2352 x 1568 pixels.
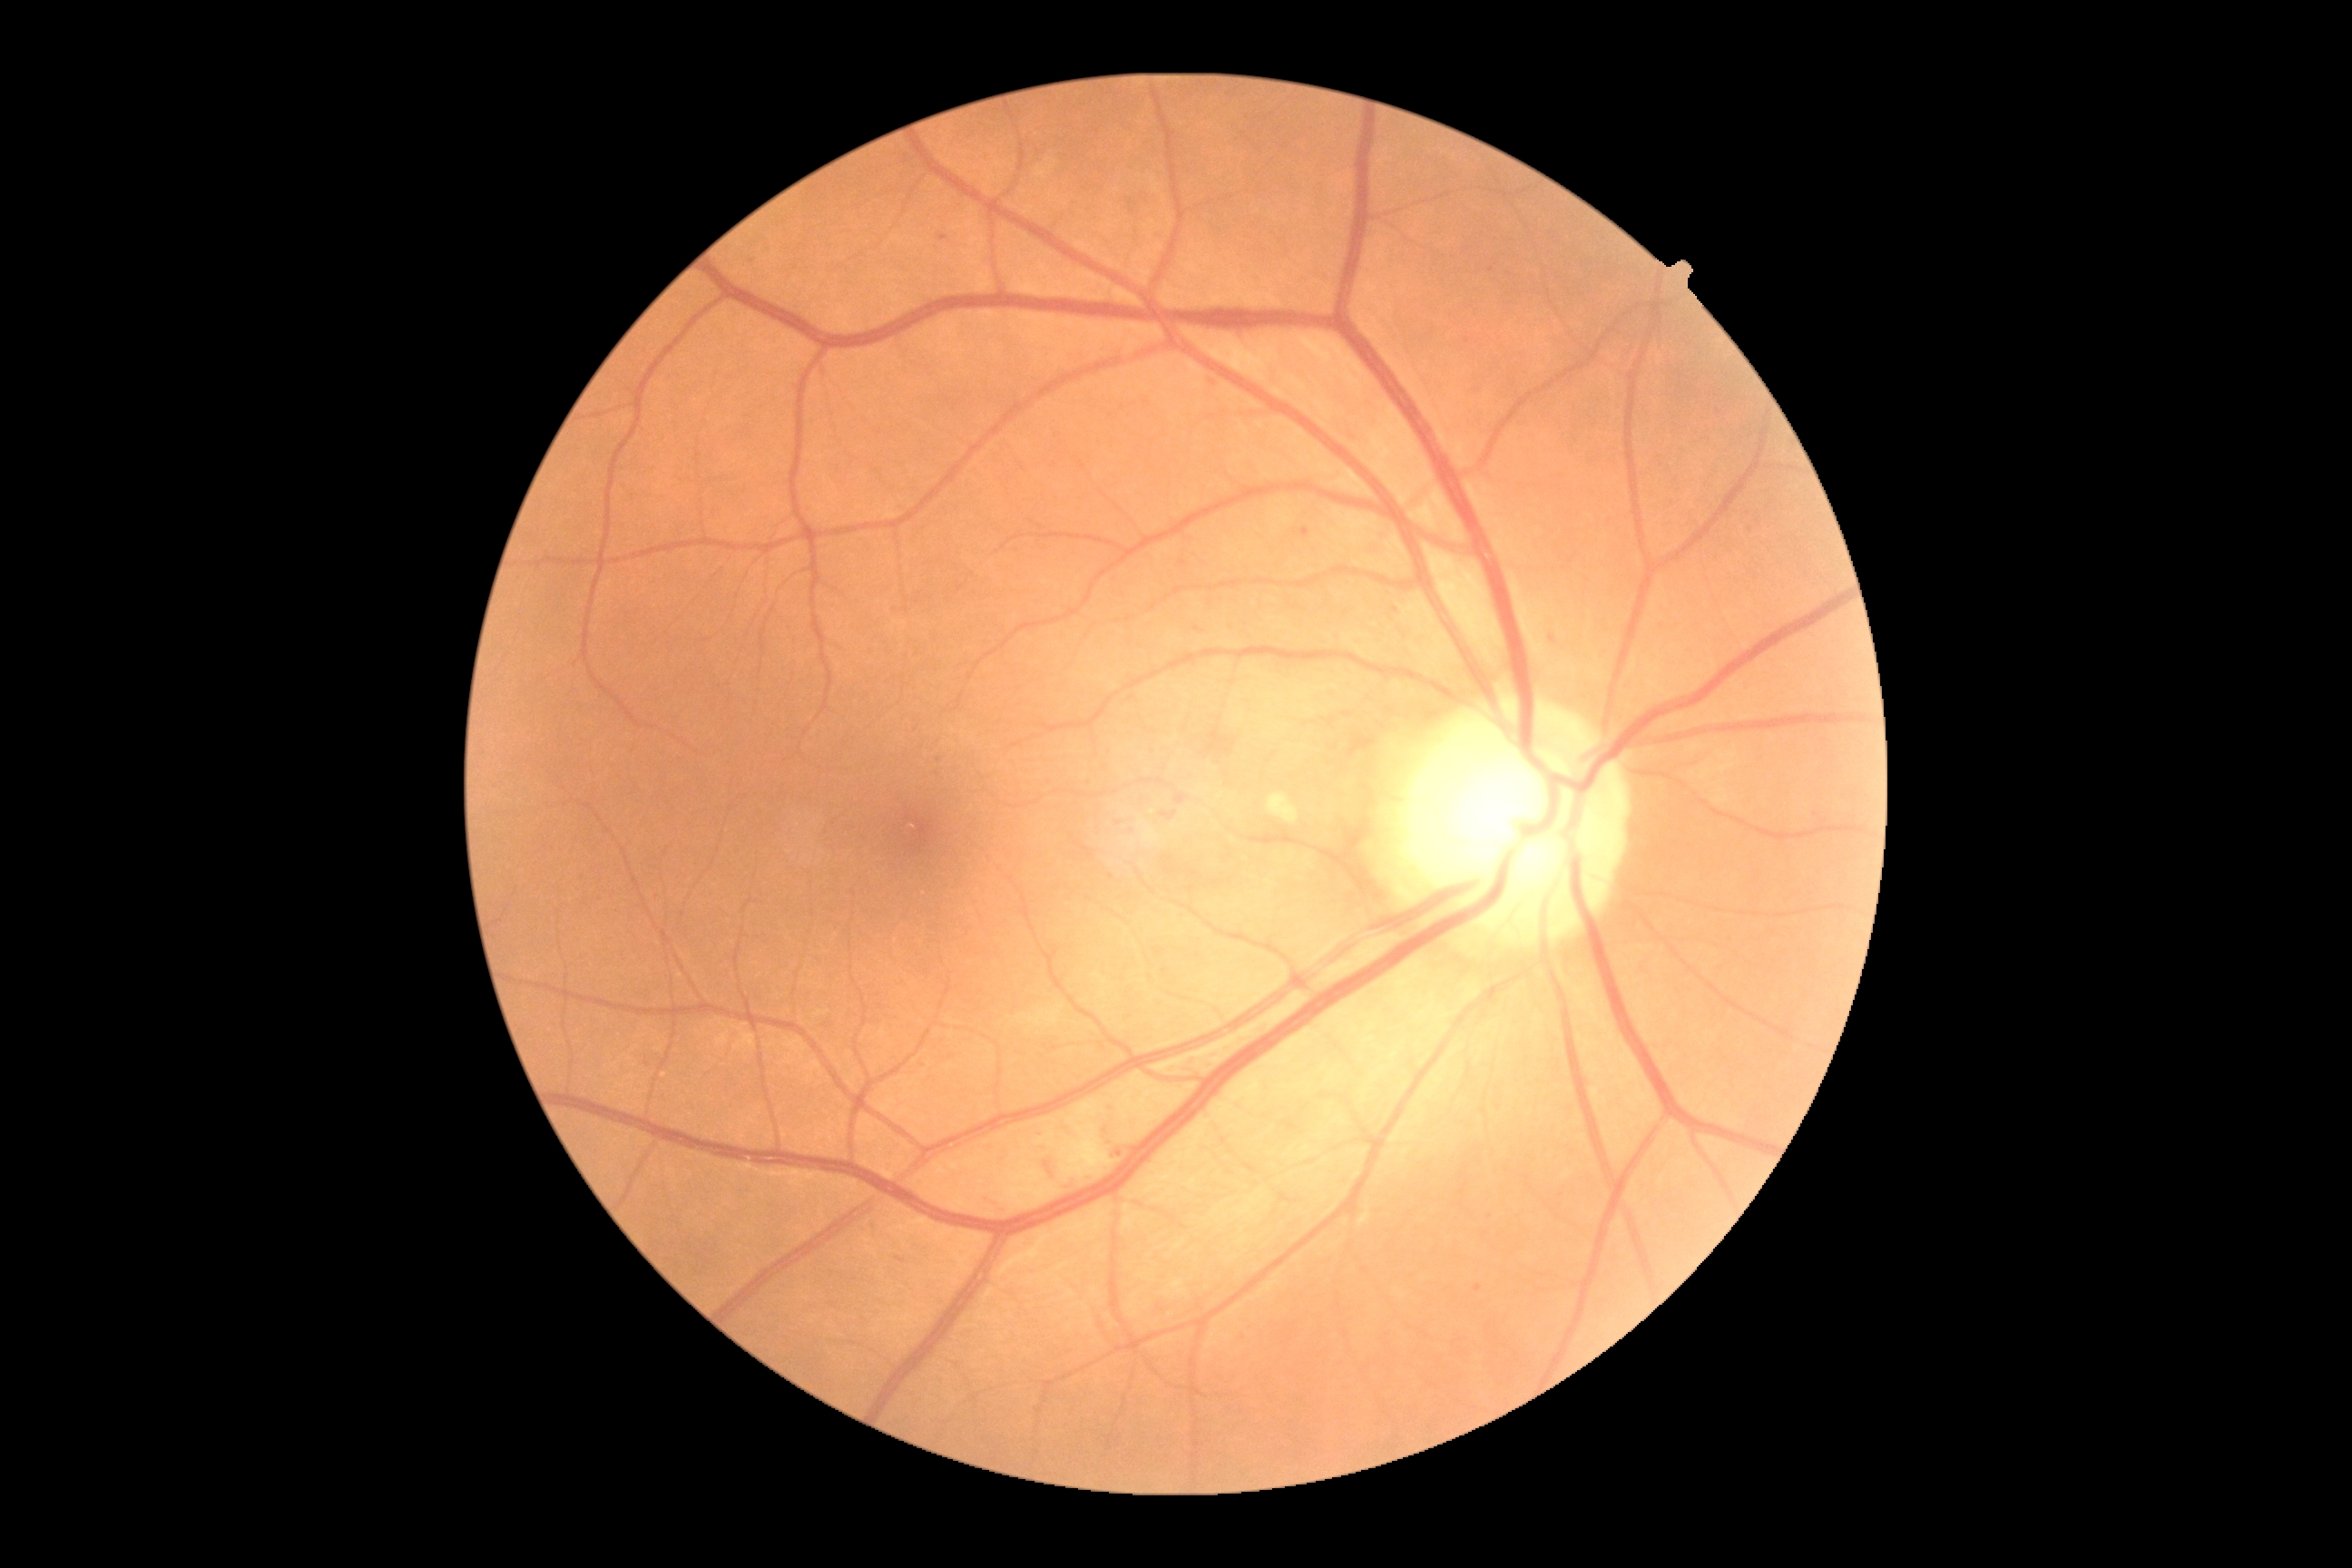 Diabetic retinopathy (DR) is grade 2.